FOV: 45 degrees — 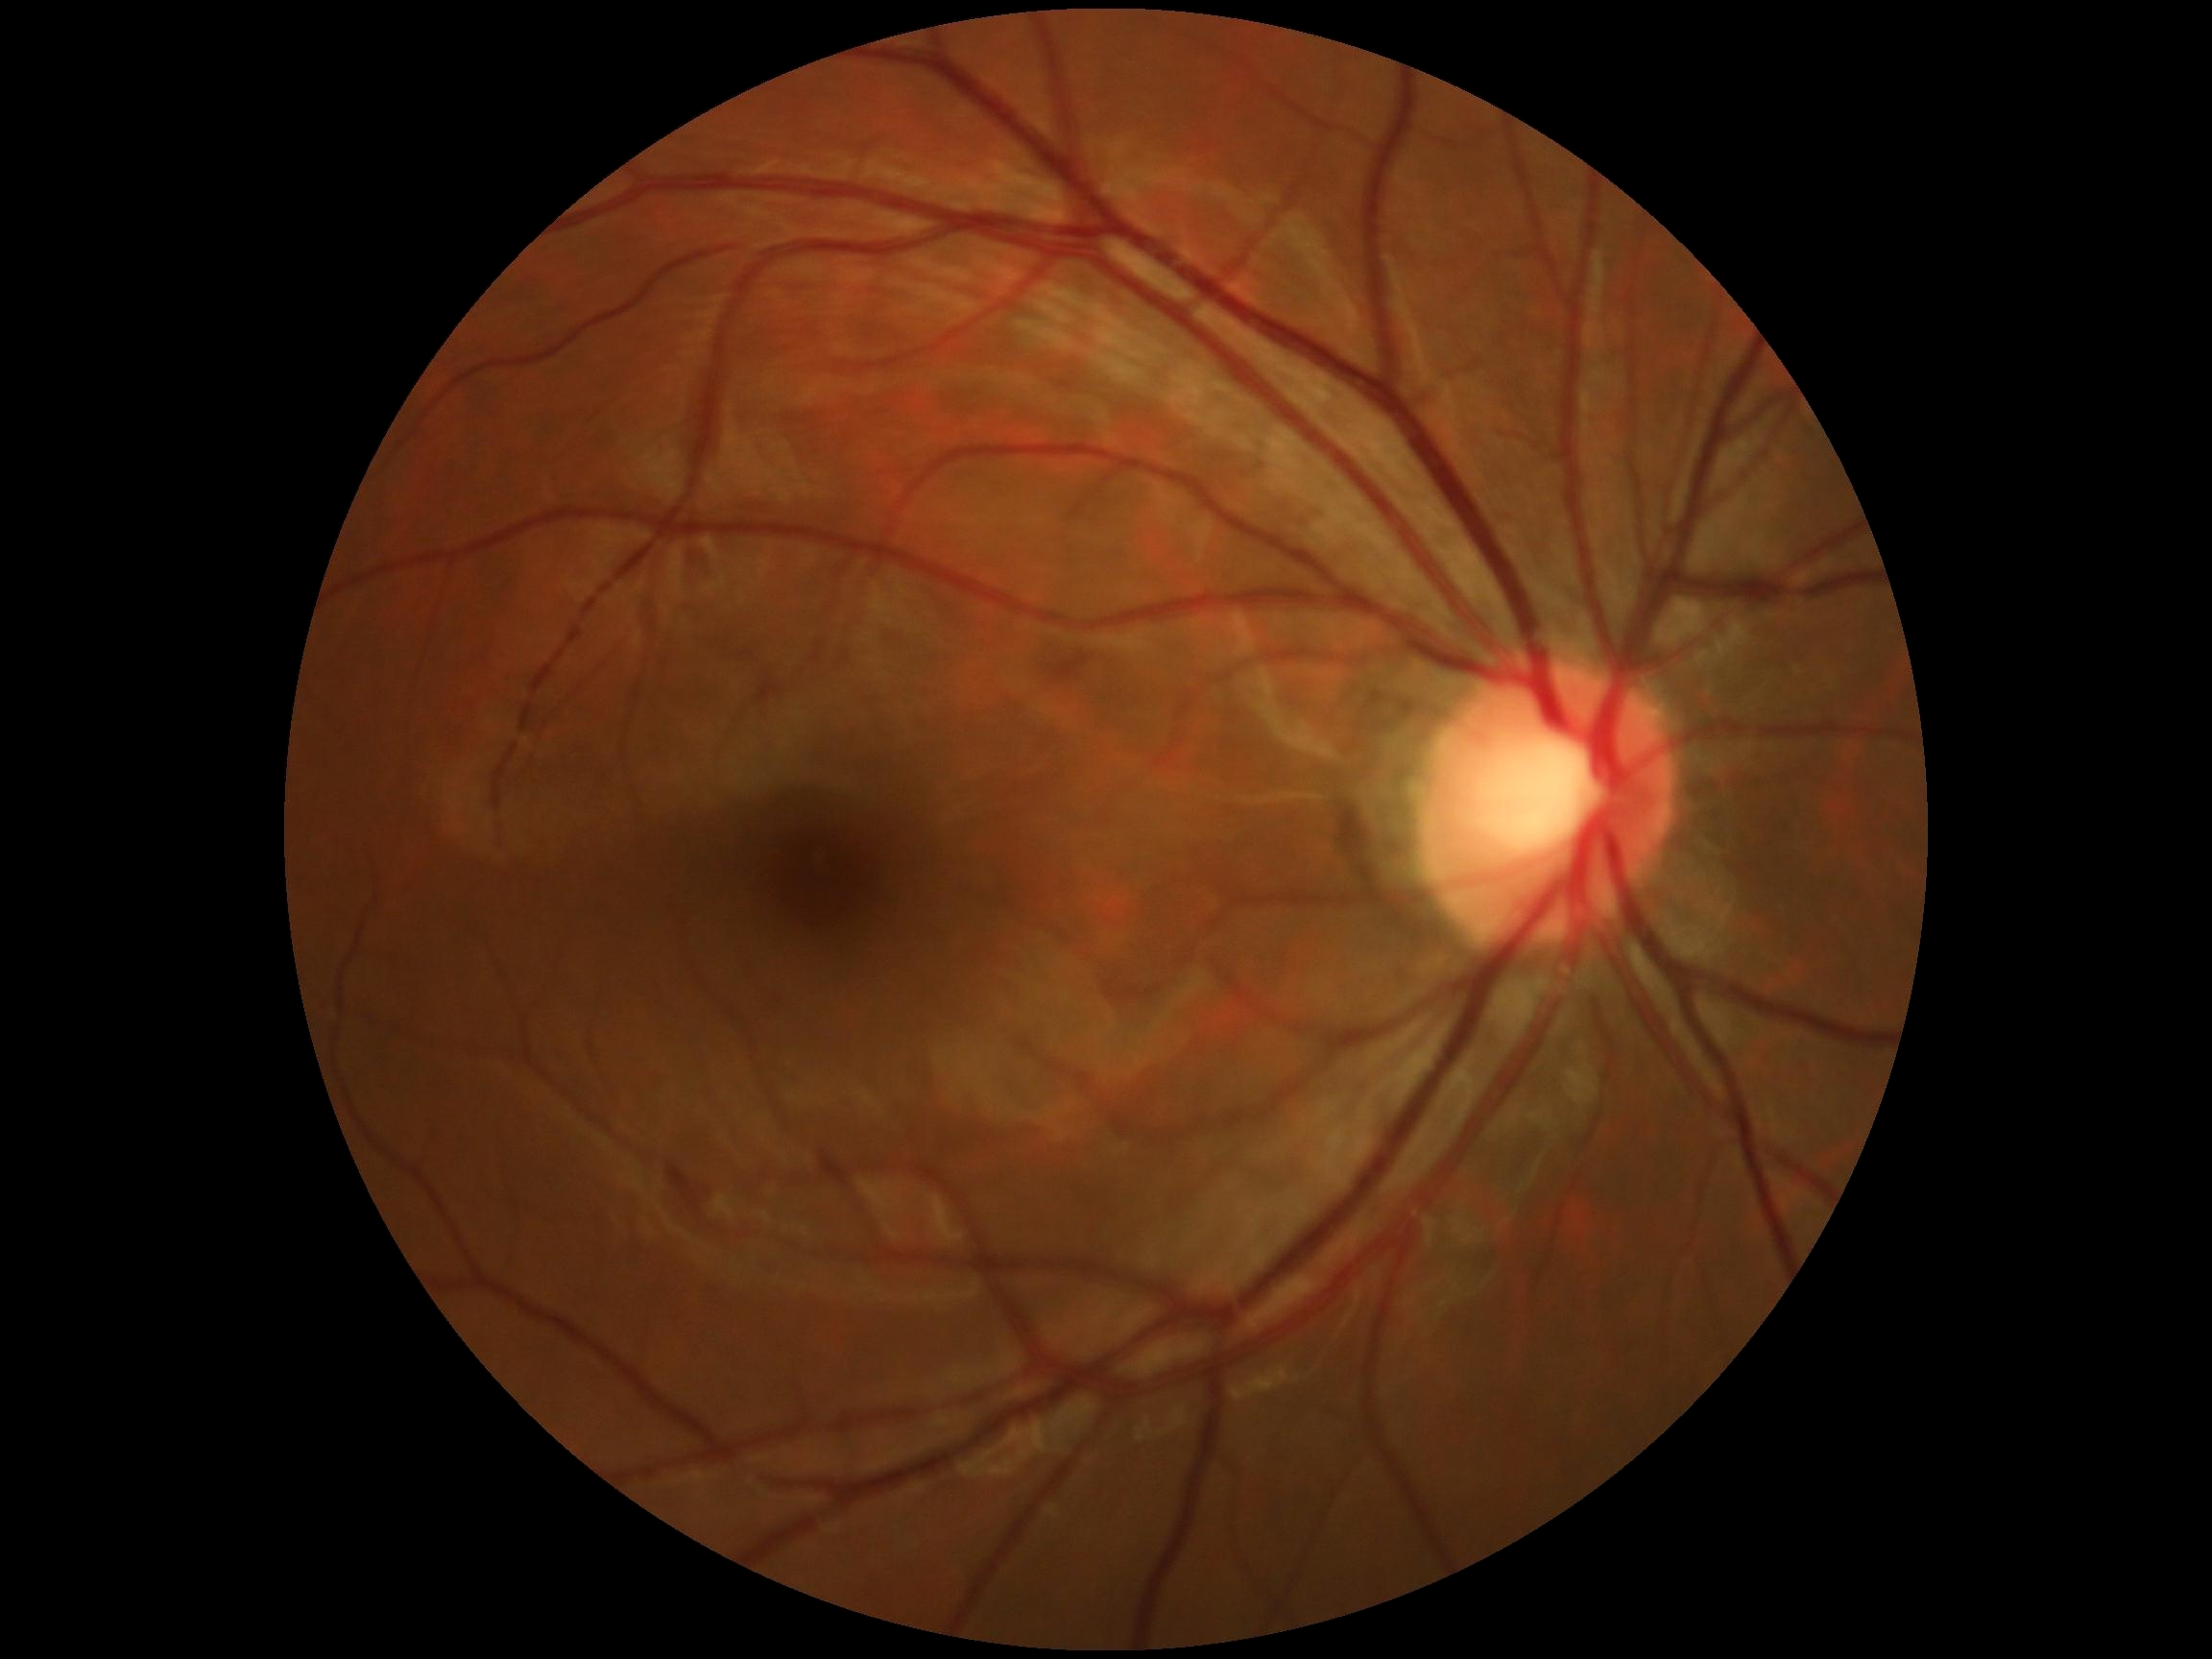

DR severity: 0/4.